848 by 848 pixels · camera: NIDEK AFC-230 · nonmydriatic · 45 degree fundus photograph · modified Davis classification — 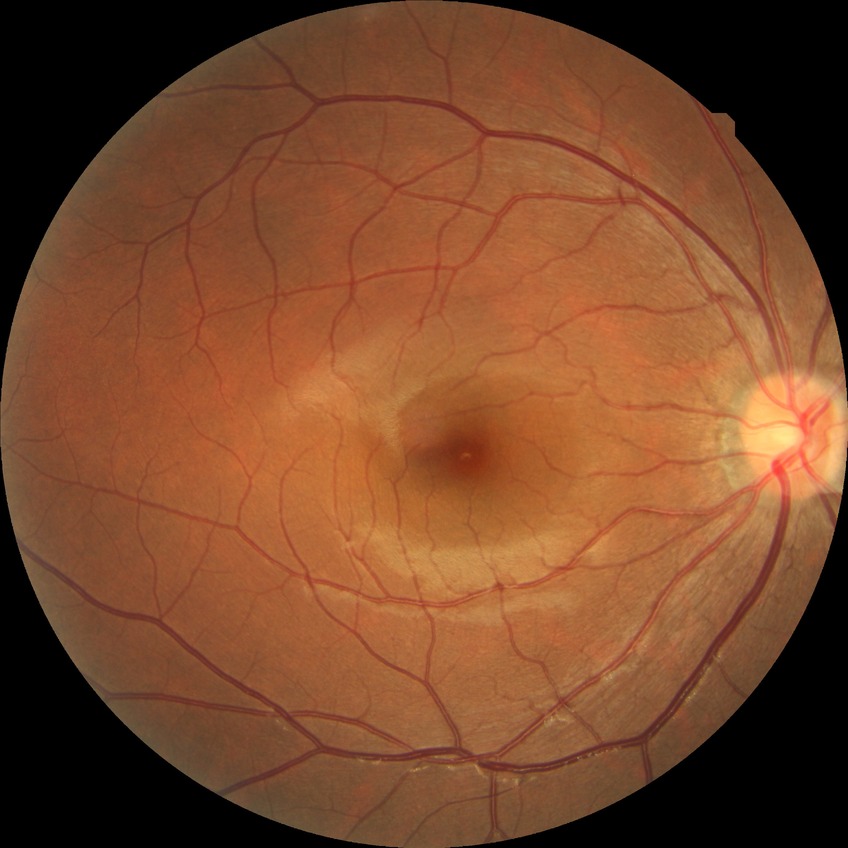 Diabetic retinopathy severity: no diabetic retinopathy.